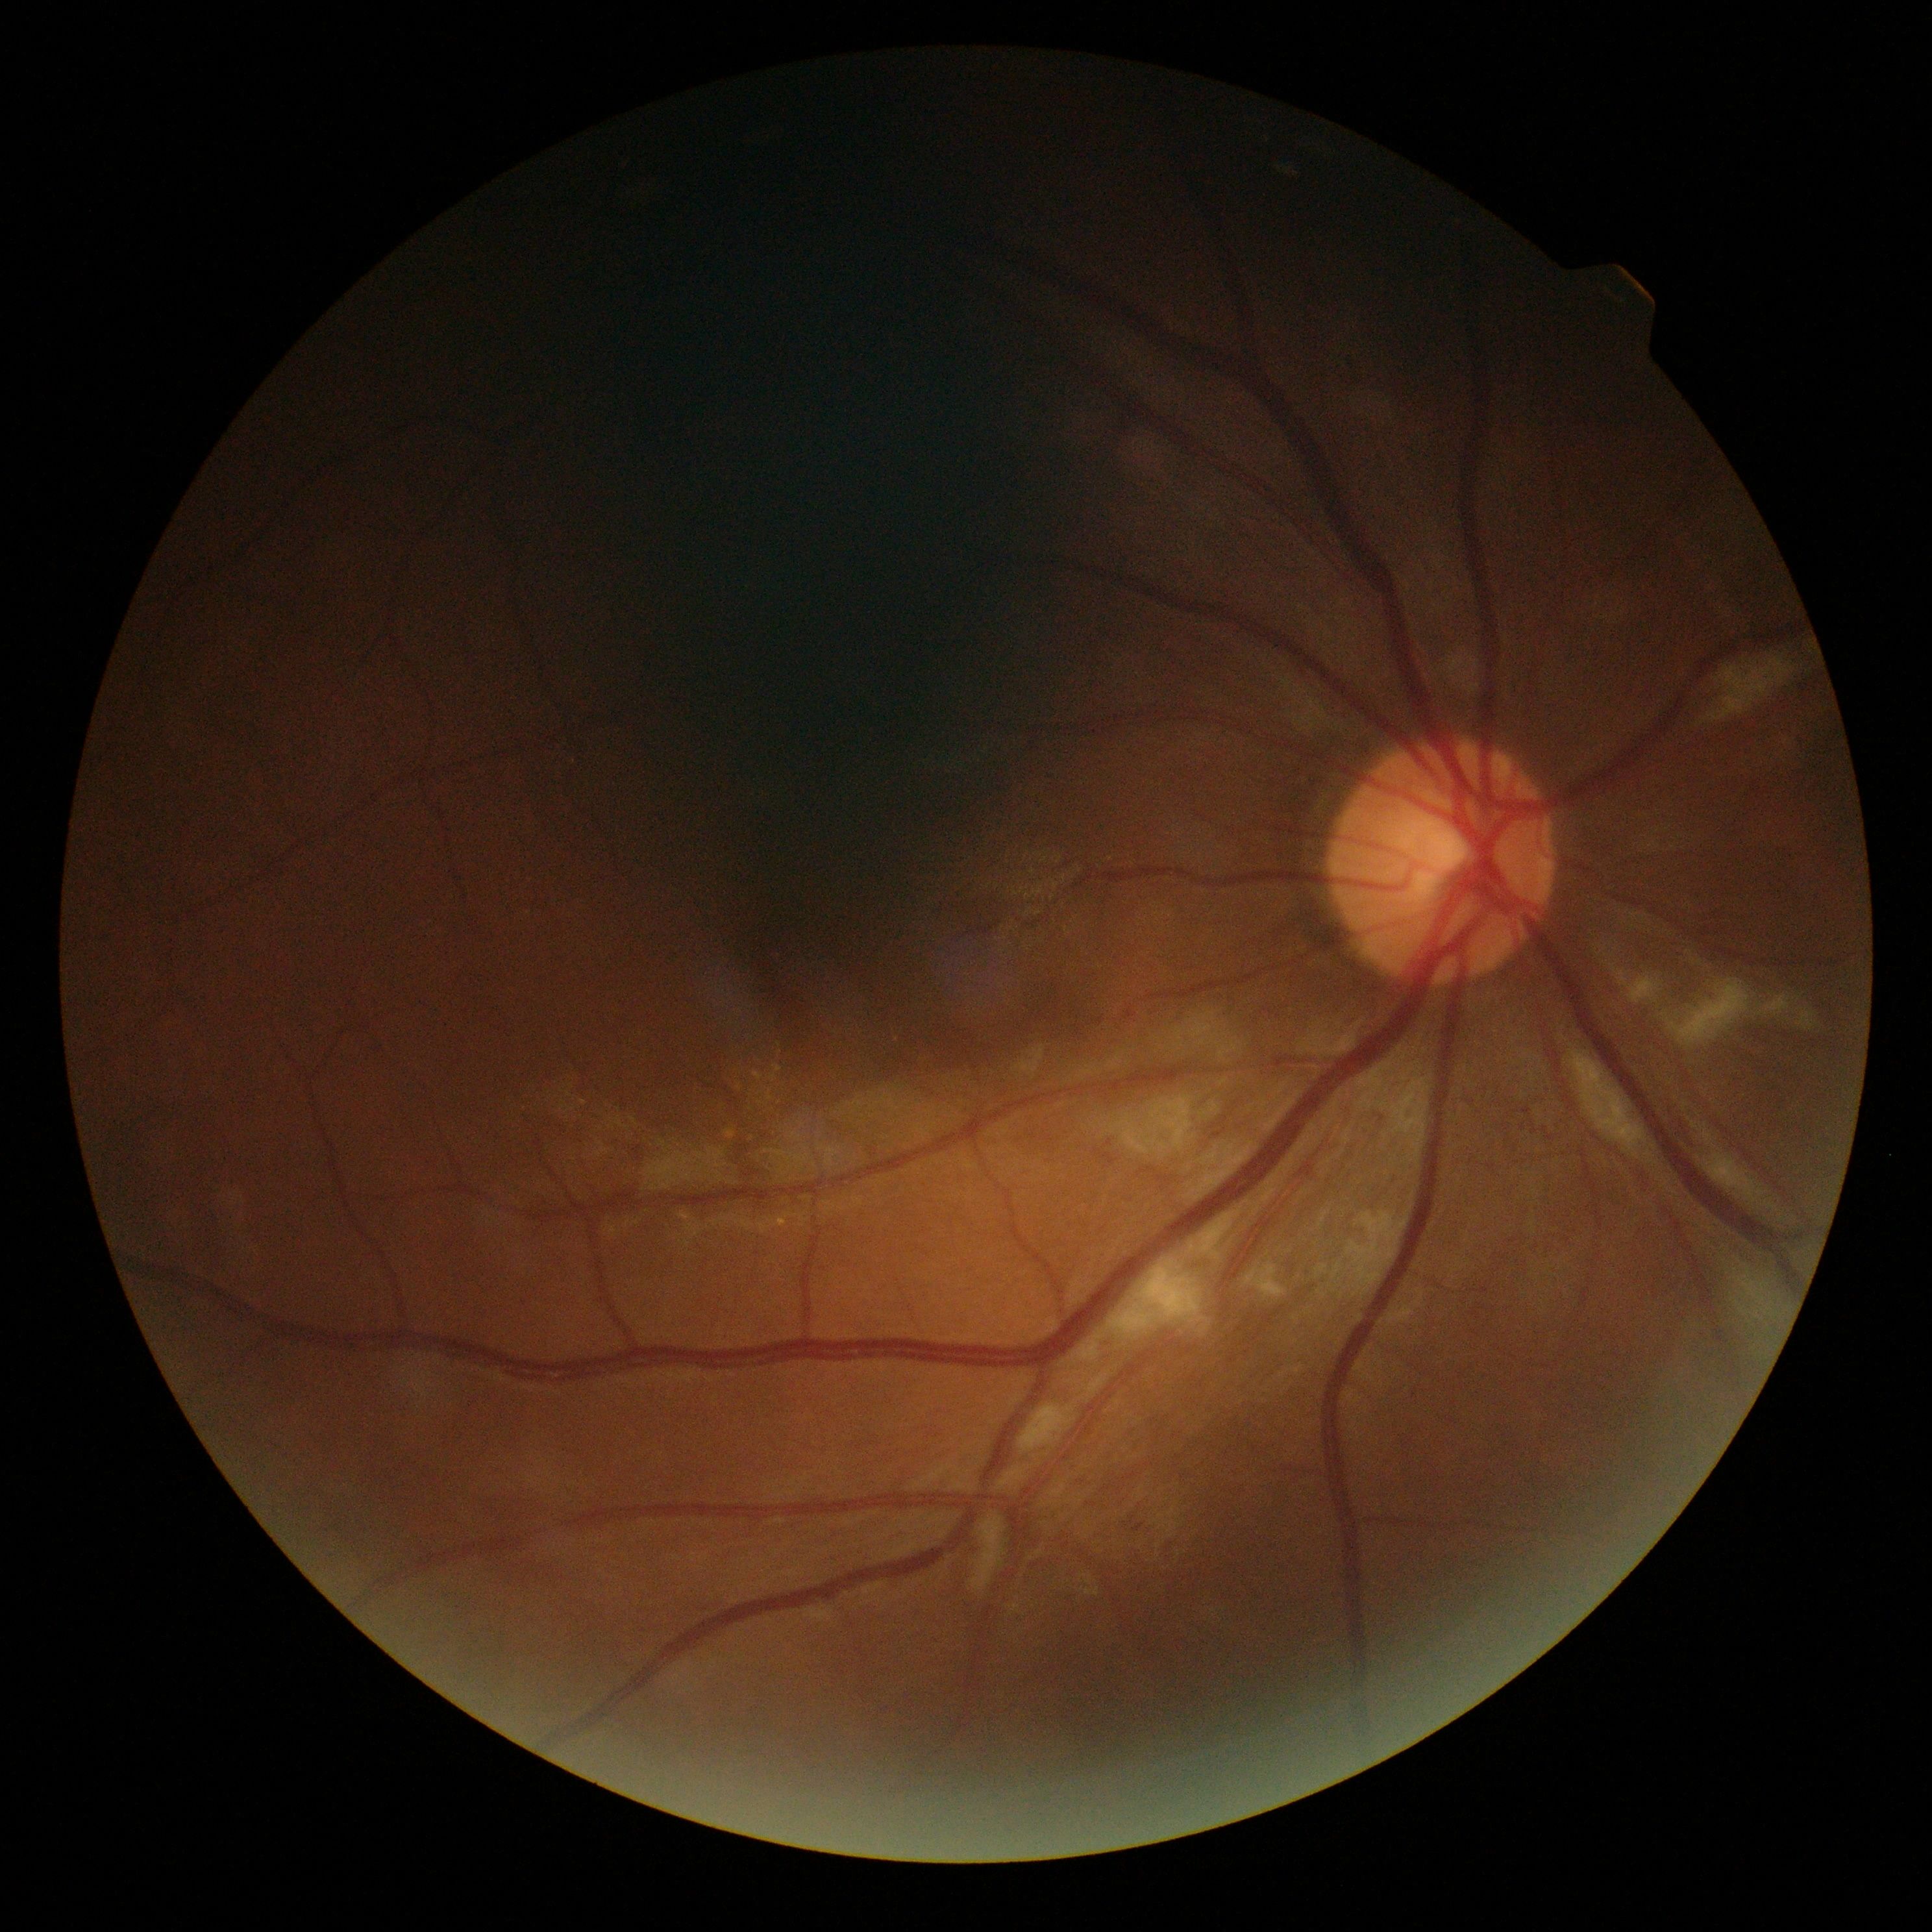

DR = 2/4 — more than just microaneurysms but less than severe NPDR, DR class = non-proliferative diabetic retinopathy.